Color fundus photograph — 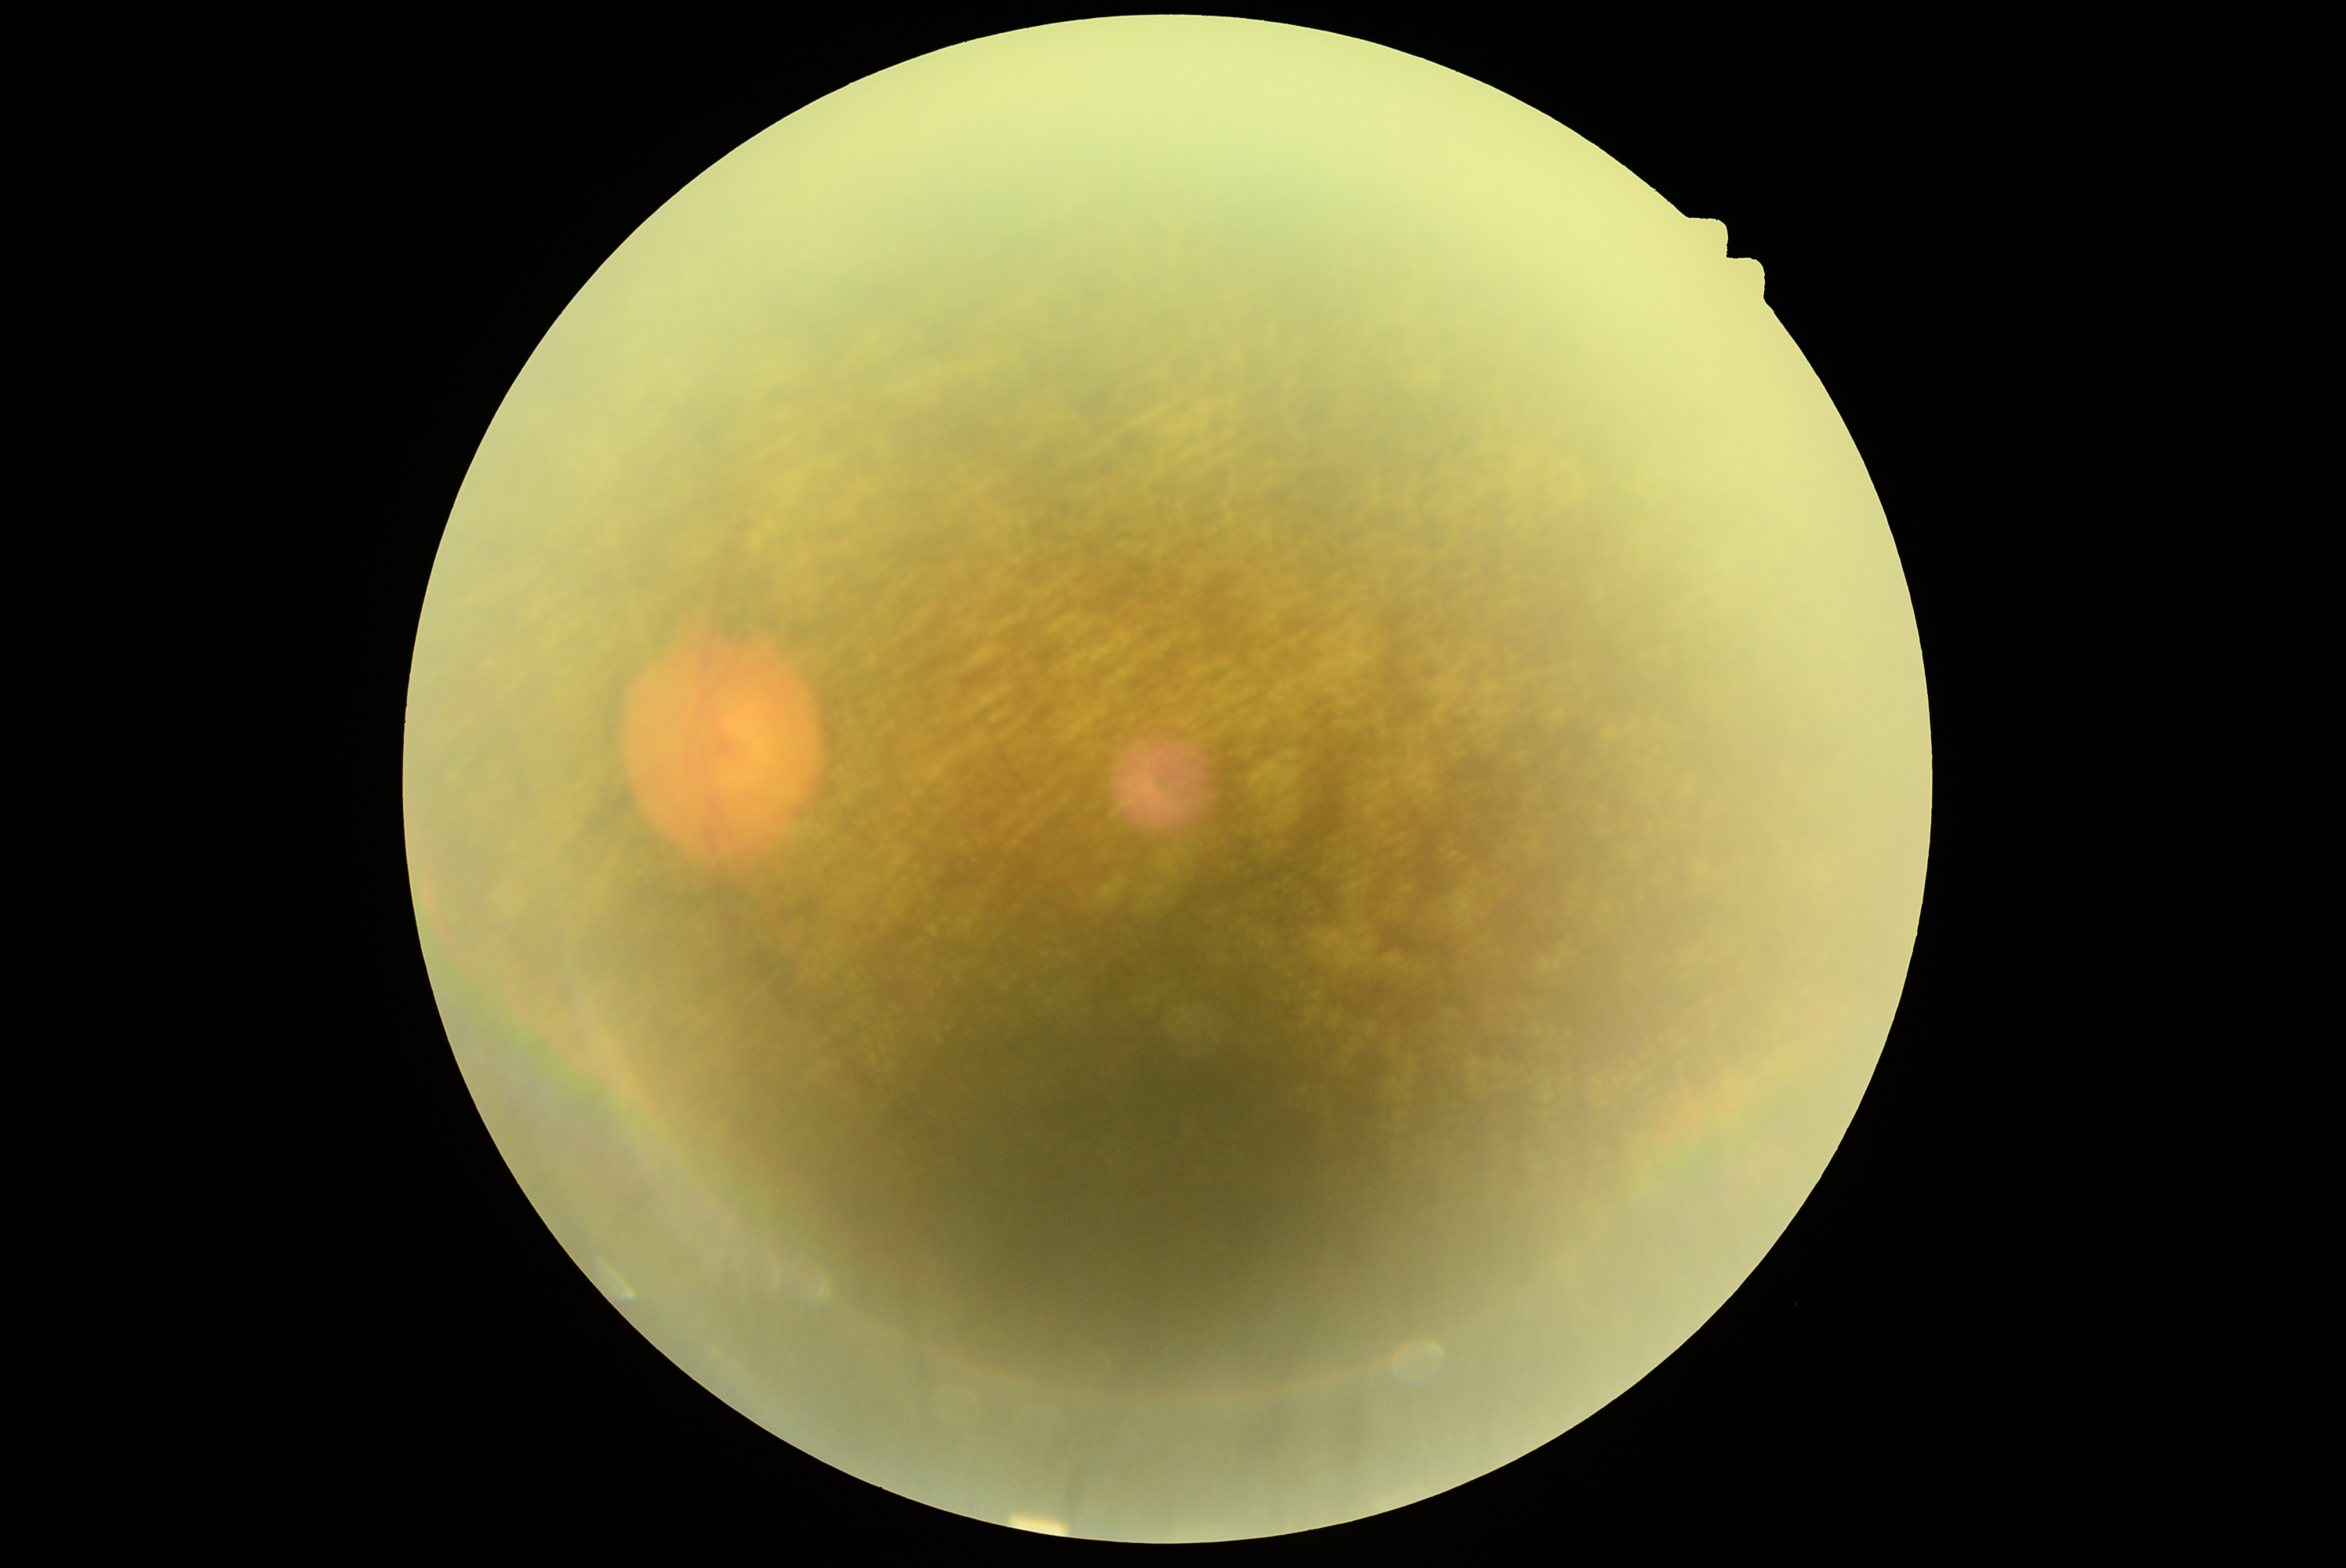

Retinopathy is ungradable due to poor image quality.